Refraction: -0.5 -0.5 × 65° · color fundus image · sex: male · axial length: 24.19 mm — 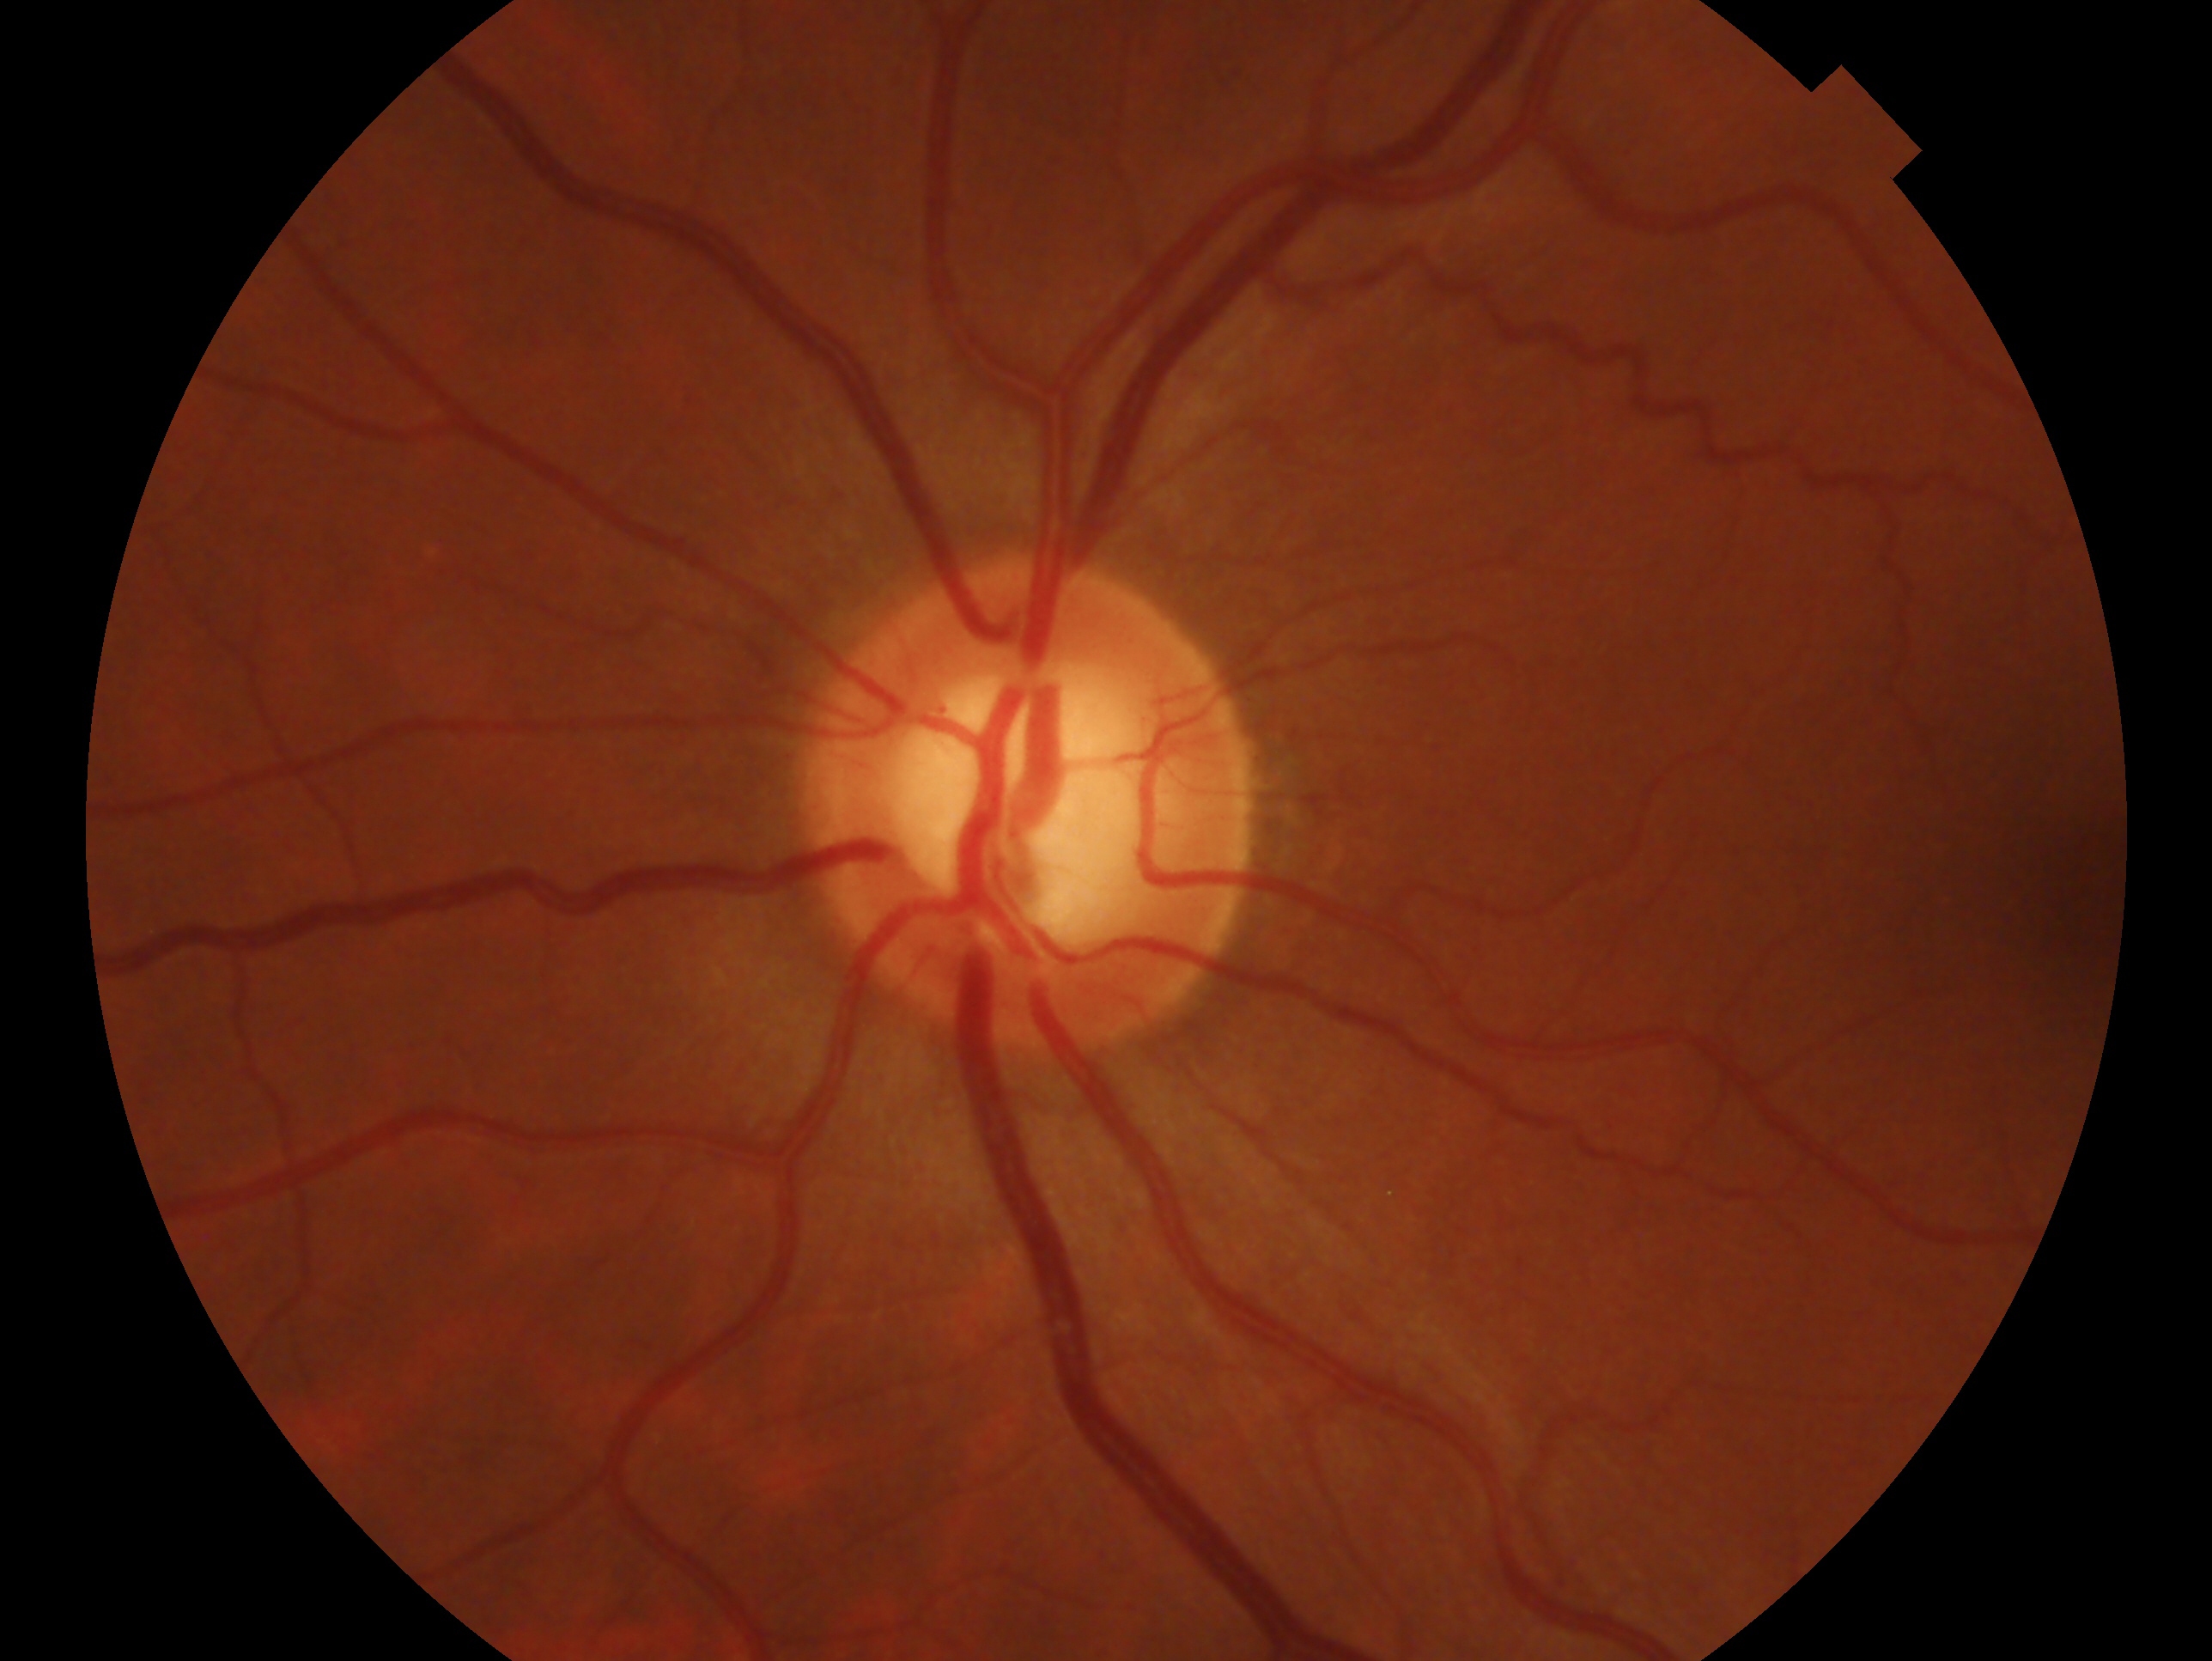
{"eye": "left", "glaucoma_dx": "no glaucoma"}